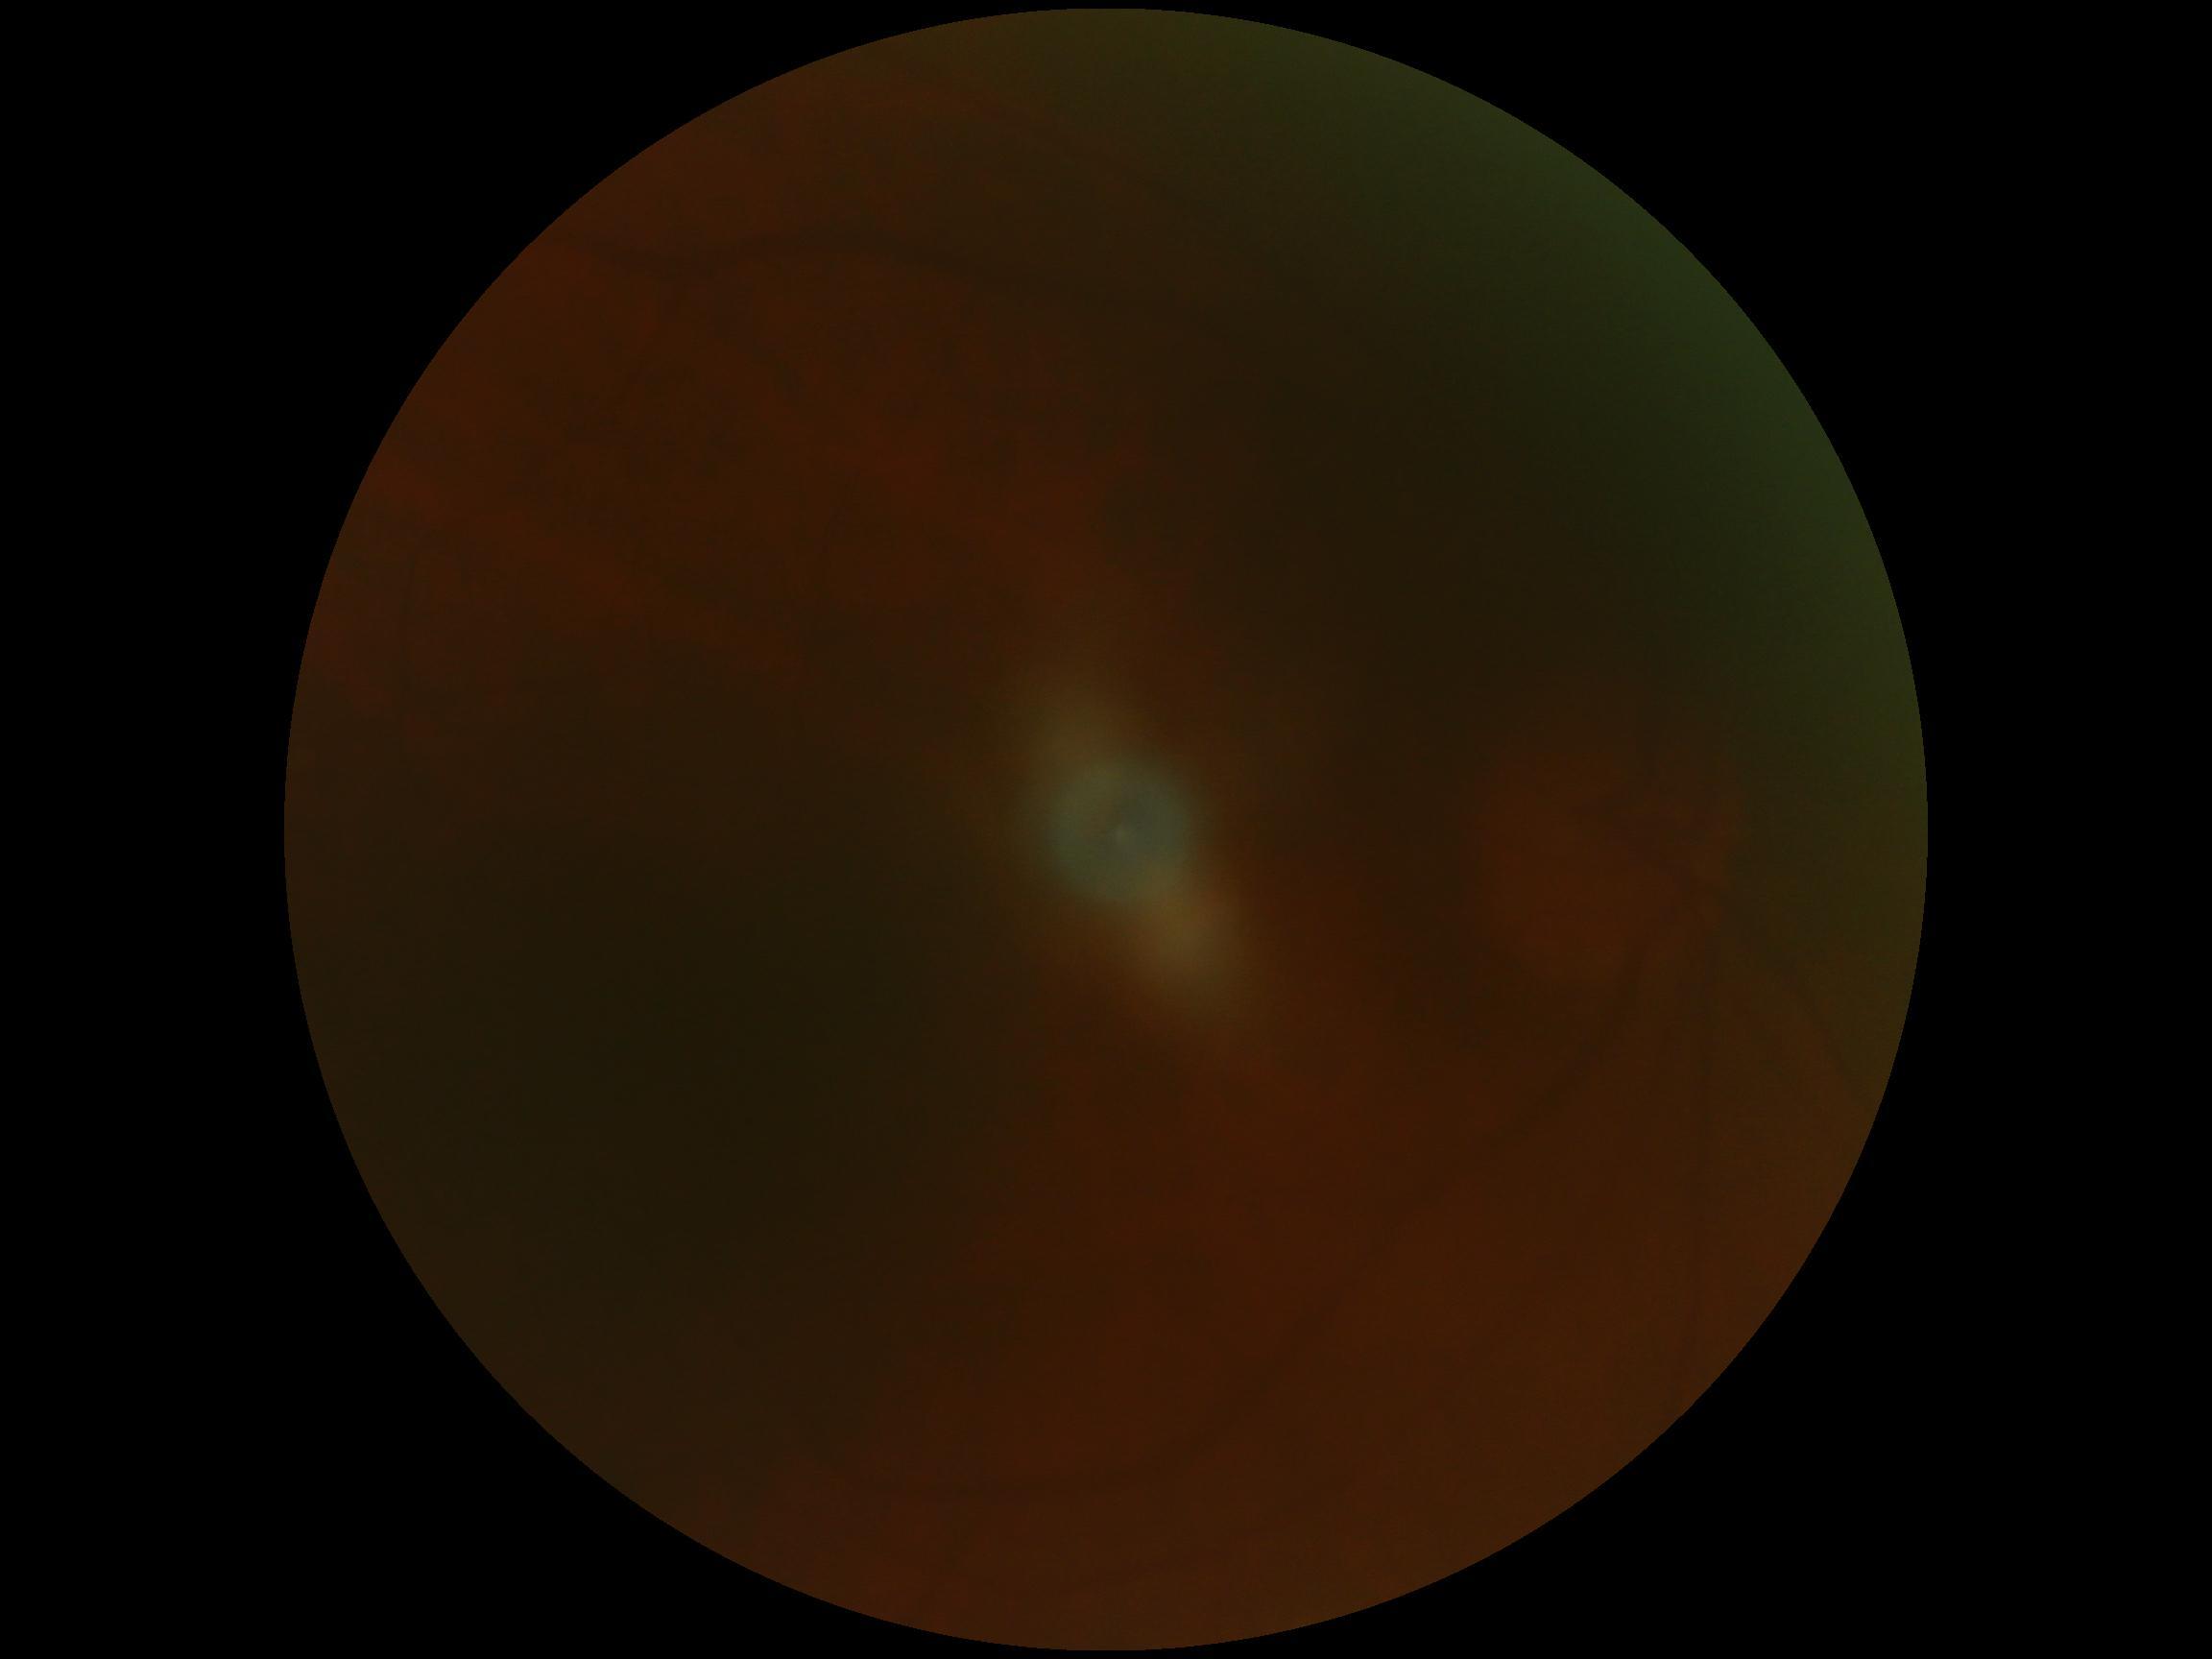

DR: ungradable